Image size 2352x1568
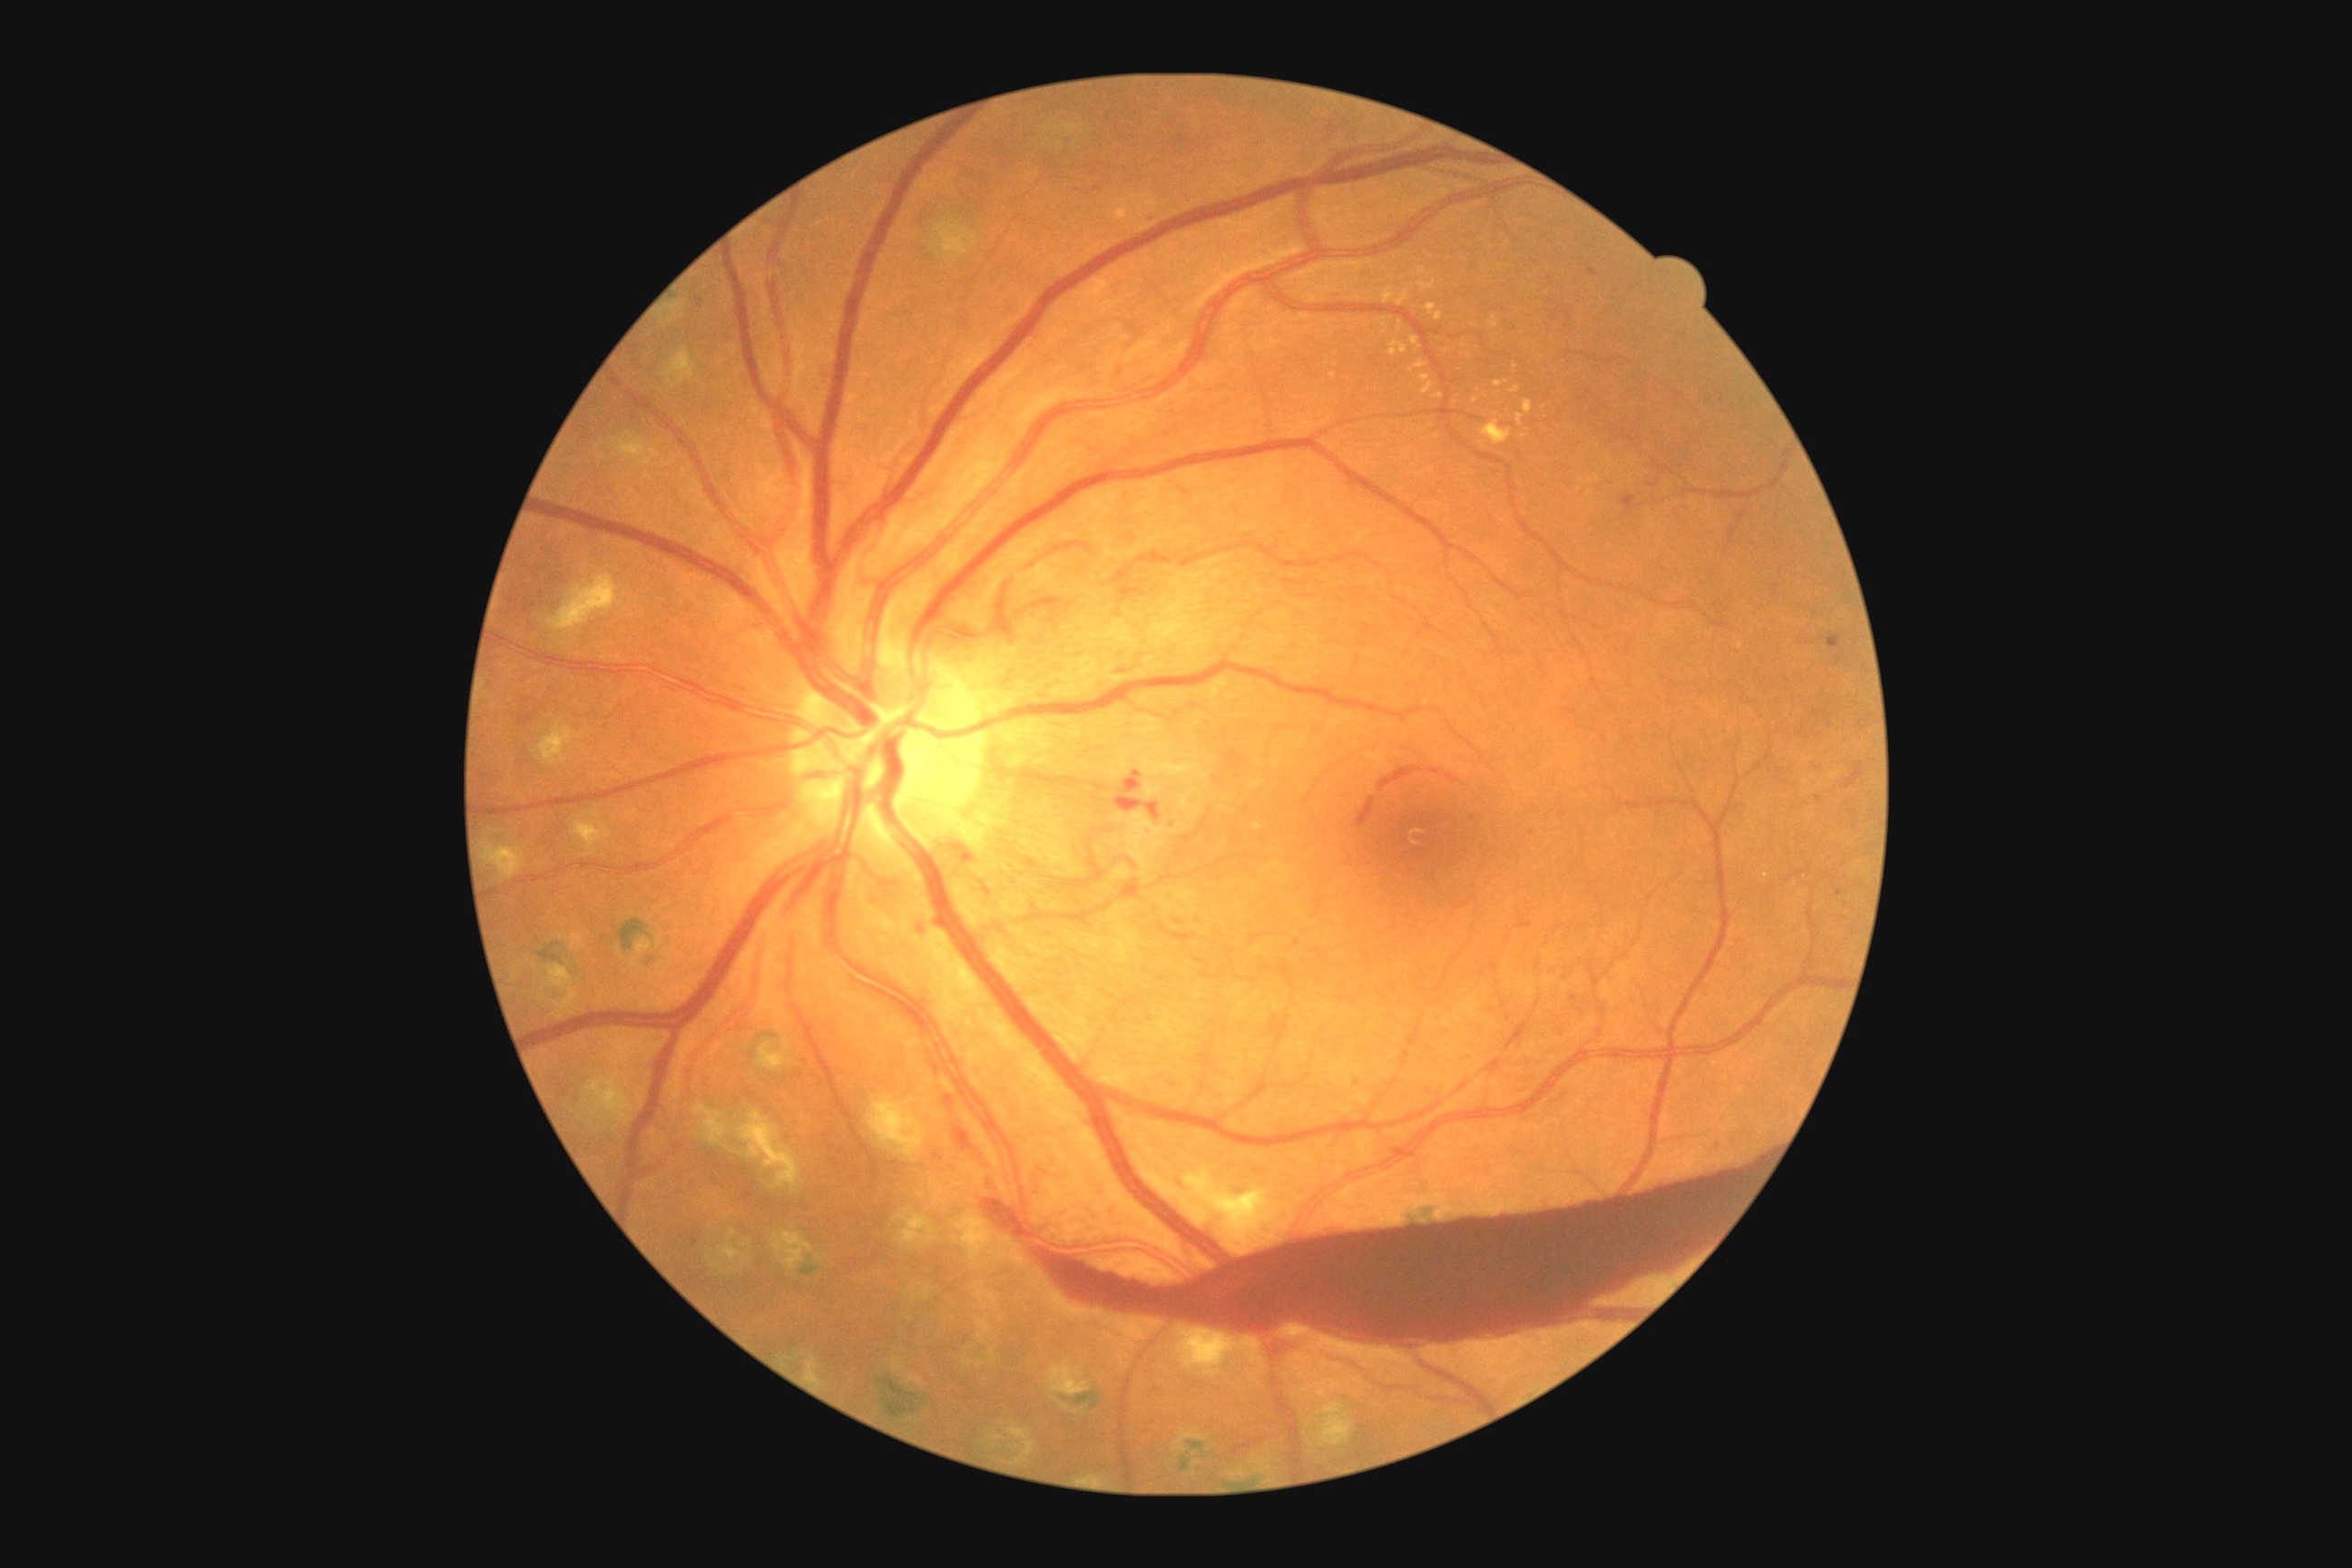 DR severity: grade 4 (PDR) — neovascularization and/or vitreous/pre-retinal hemorrhage.